Camera: Clarity RetCam 3 (130° FOV) · wide-field contact fundus photograph of an infant · image size 640x480:
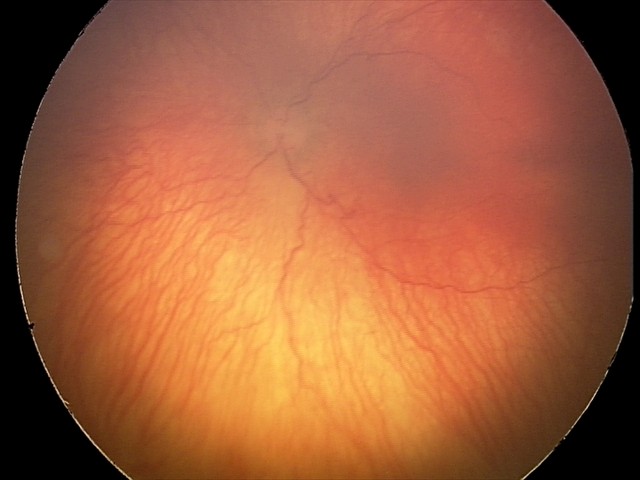

Plus form = present — abnormal dilation and tortuosity of the posterior pole retinal vessels, screening diagnosis = aggressive retinopathy of prematurity — rapidly progressive severe ROP with prominent plus disease, often without classic stage progression.